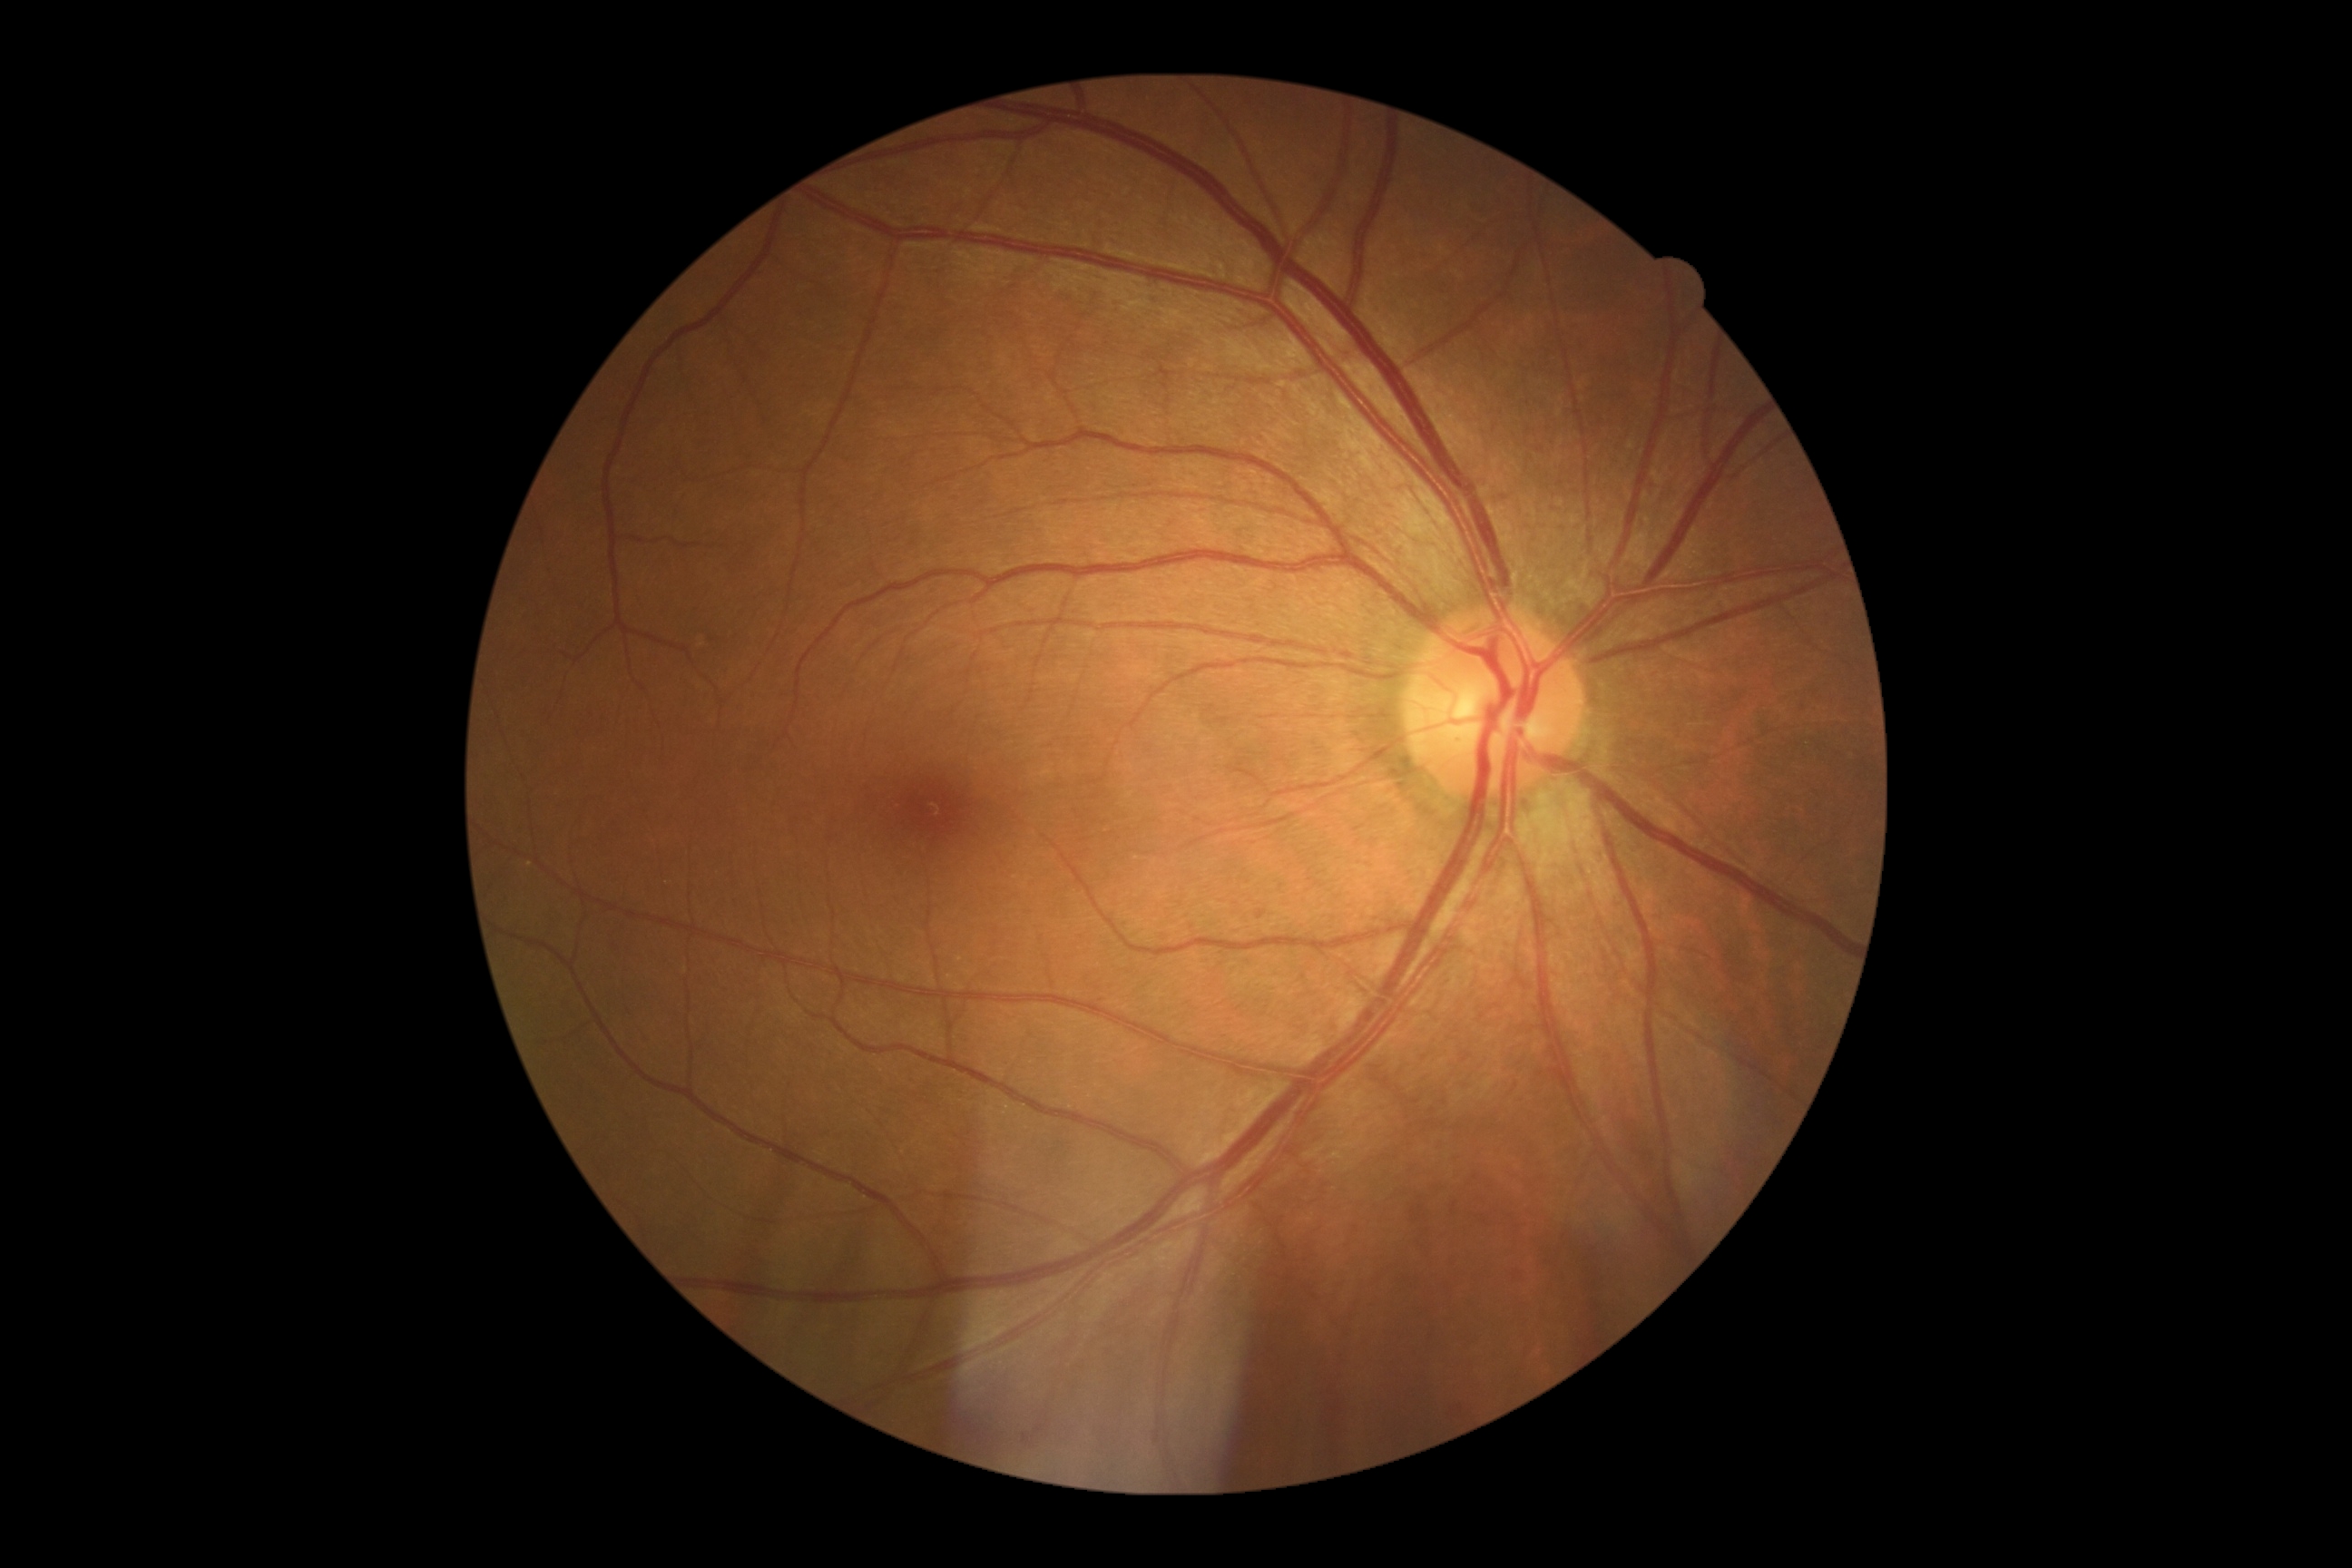
diabetic retinopathy: 1.